CFP: 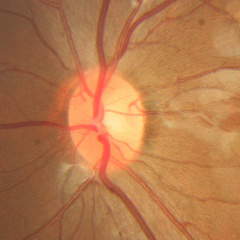
There is evidence of no signs of glaucoma.